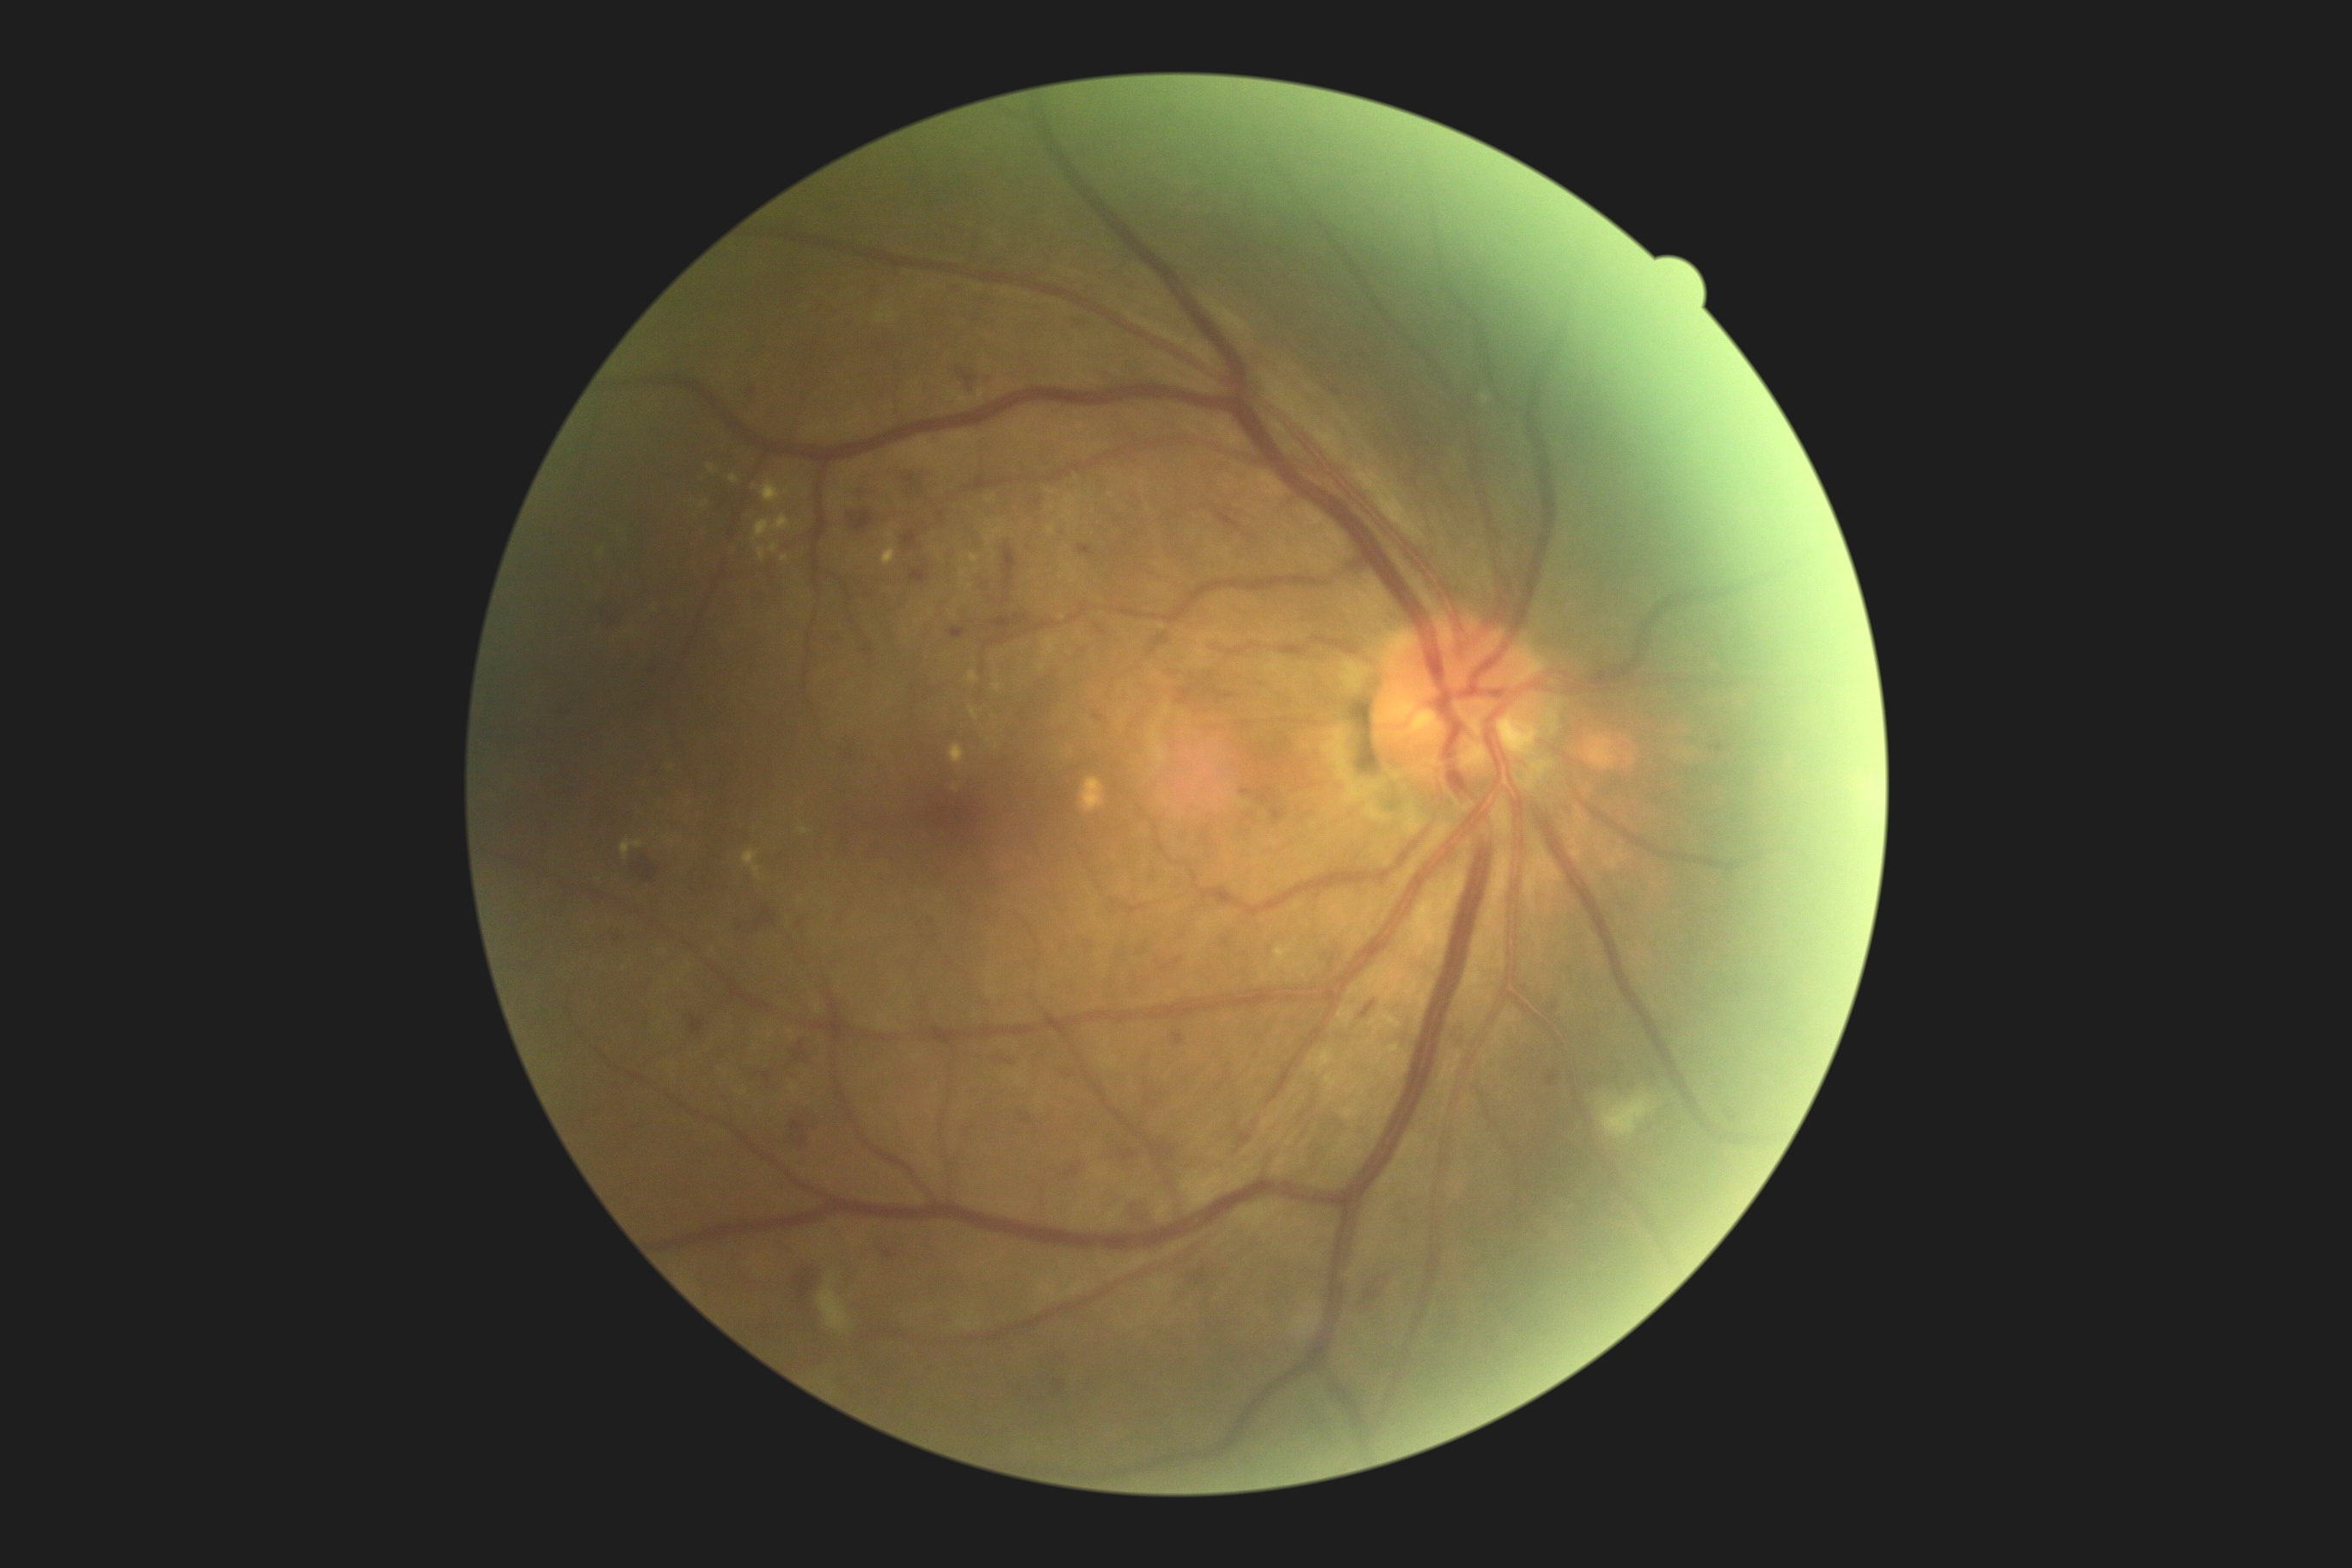 DR severity: 2
A subset of detected lesions:
MAs (subset): bbox(1447, 1029, 1462, 1050), bbox(1019, 1113, 1031, 1124), bbox(833, 917, 843, 931), bbox(1057, 1380, 1063, 1392), bbox(1069, 1167, 1081, 1175), bbox(1320, 1239, 1328, 1244), bbox(1015, 616, 1022, 625), bbox(1548, 1072, 1560, 1086), bbox(1715, 744, 1724, 752), bbox(763, 1072, 771, 1079), bbox(646, 668, 651, 678), bbox(864, 647, 873, 656), bbox(1211, 689, 1235, 699)
MAs (small, approximate centers) near <point>1071, 1075</point>, <point>1142, 950</point>, <point>619, 938</point>, <point>752, 392</point>, <point>1554, 1008</point>
HEs (subset): bbox(601, 608, 625, 630), bbox(1077, 546, 1094, 556), bbox(1363, 1001, 1376, 1017), bbox(1216, 511, 1240, 530), bbox(848, 510, 874, 532), bbox(1125, 1196, 1165, 1223), bbox(855, 487, 876, 503), bbox(790, 1261, 821, 1299), bbox(910, 568, 929, 582), bbox(630, 850, 659, 888), bbox(735, 907, 778, 940)
EXs (subset): bbox(730, 474, 740, 486), bbox(781, 556, 790, 563), bbox(738, 1089, 749, 1094), bbox(799, 828, 809, 835), bbox(1337, 1005, 1354, 1026), bbox(1273, 941, 1295, 969), bbox(1325, 1074, 1342, 1091), bbox(742, 850, 763, 879), bbox(622, 840, 644, 859), bbox(707, 465, 714, 474), bbox(984, 536, 991, 546), bbox(759, 546, 766, 563), bbox(967, 553, 981, 565)
EXs (small, approximate centers) near <point>962, 586</point>, <point>705, 504</point>, <point>790, 1032</point>, <point>969, 587</point>